Graded on the modified Davis scale.
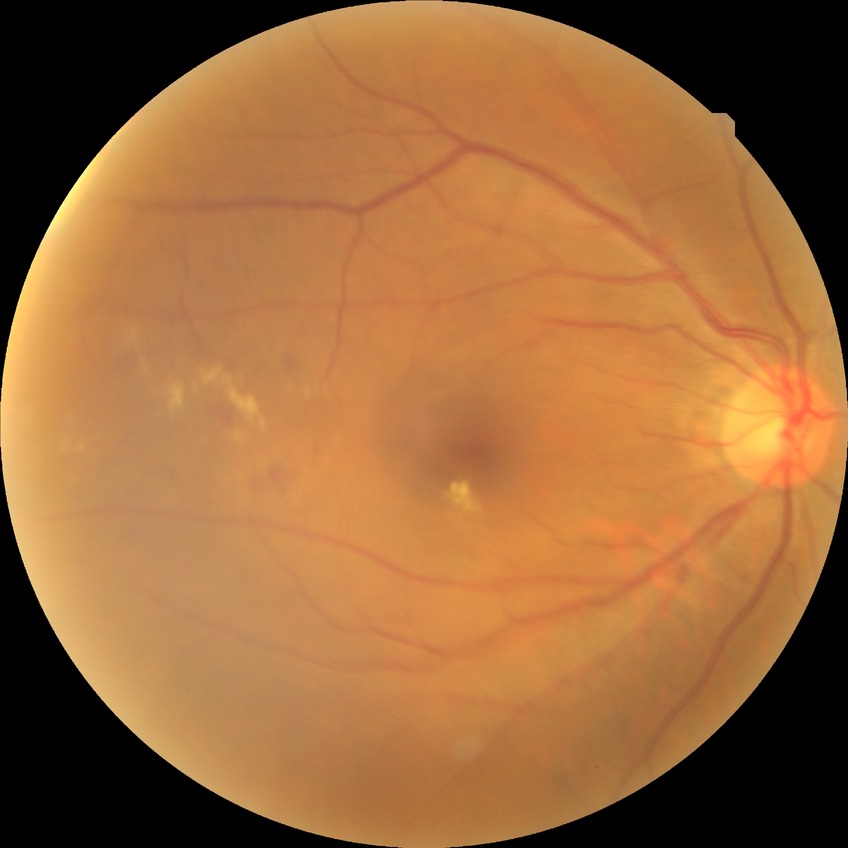

DR severity is SDR. DR class: non-proliferative diabetic retinopathy.